Retinal fundus photograph — 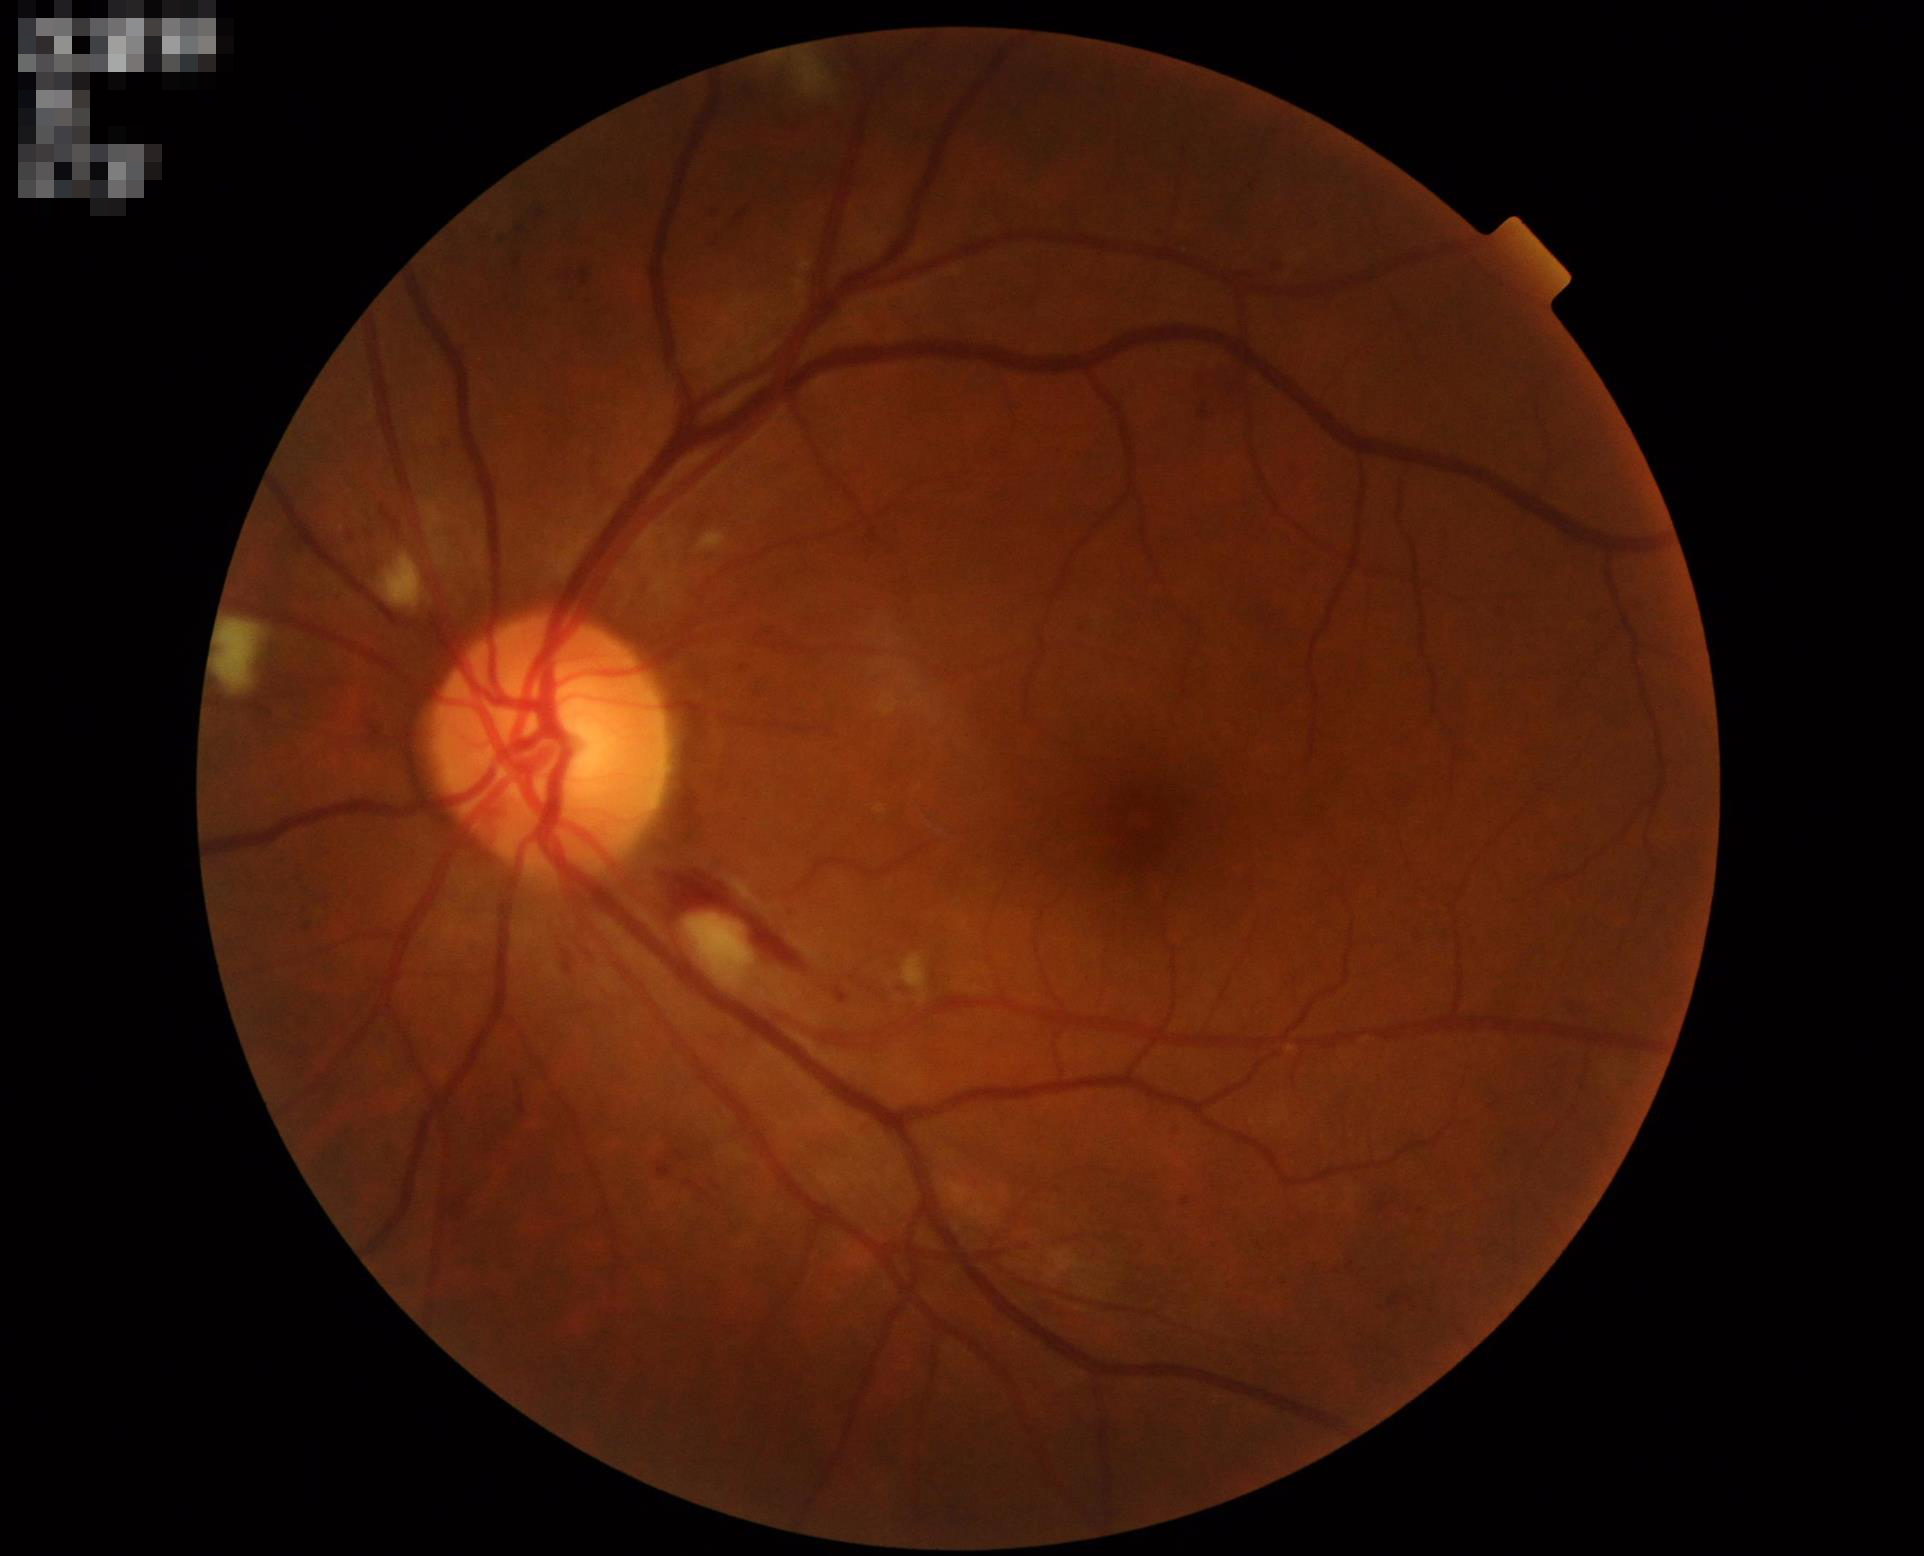 Quality assessment:
- overall: good and suitable for diagnostic use